45-degree field of view: 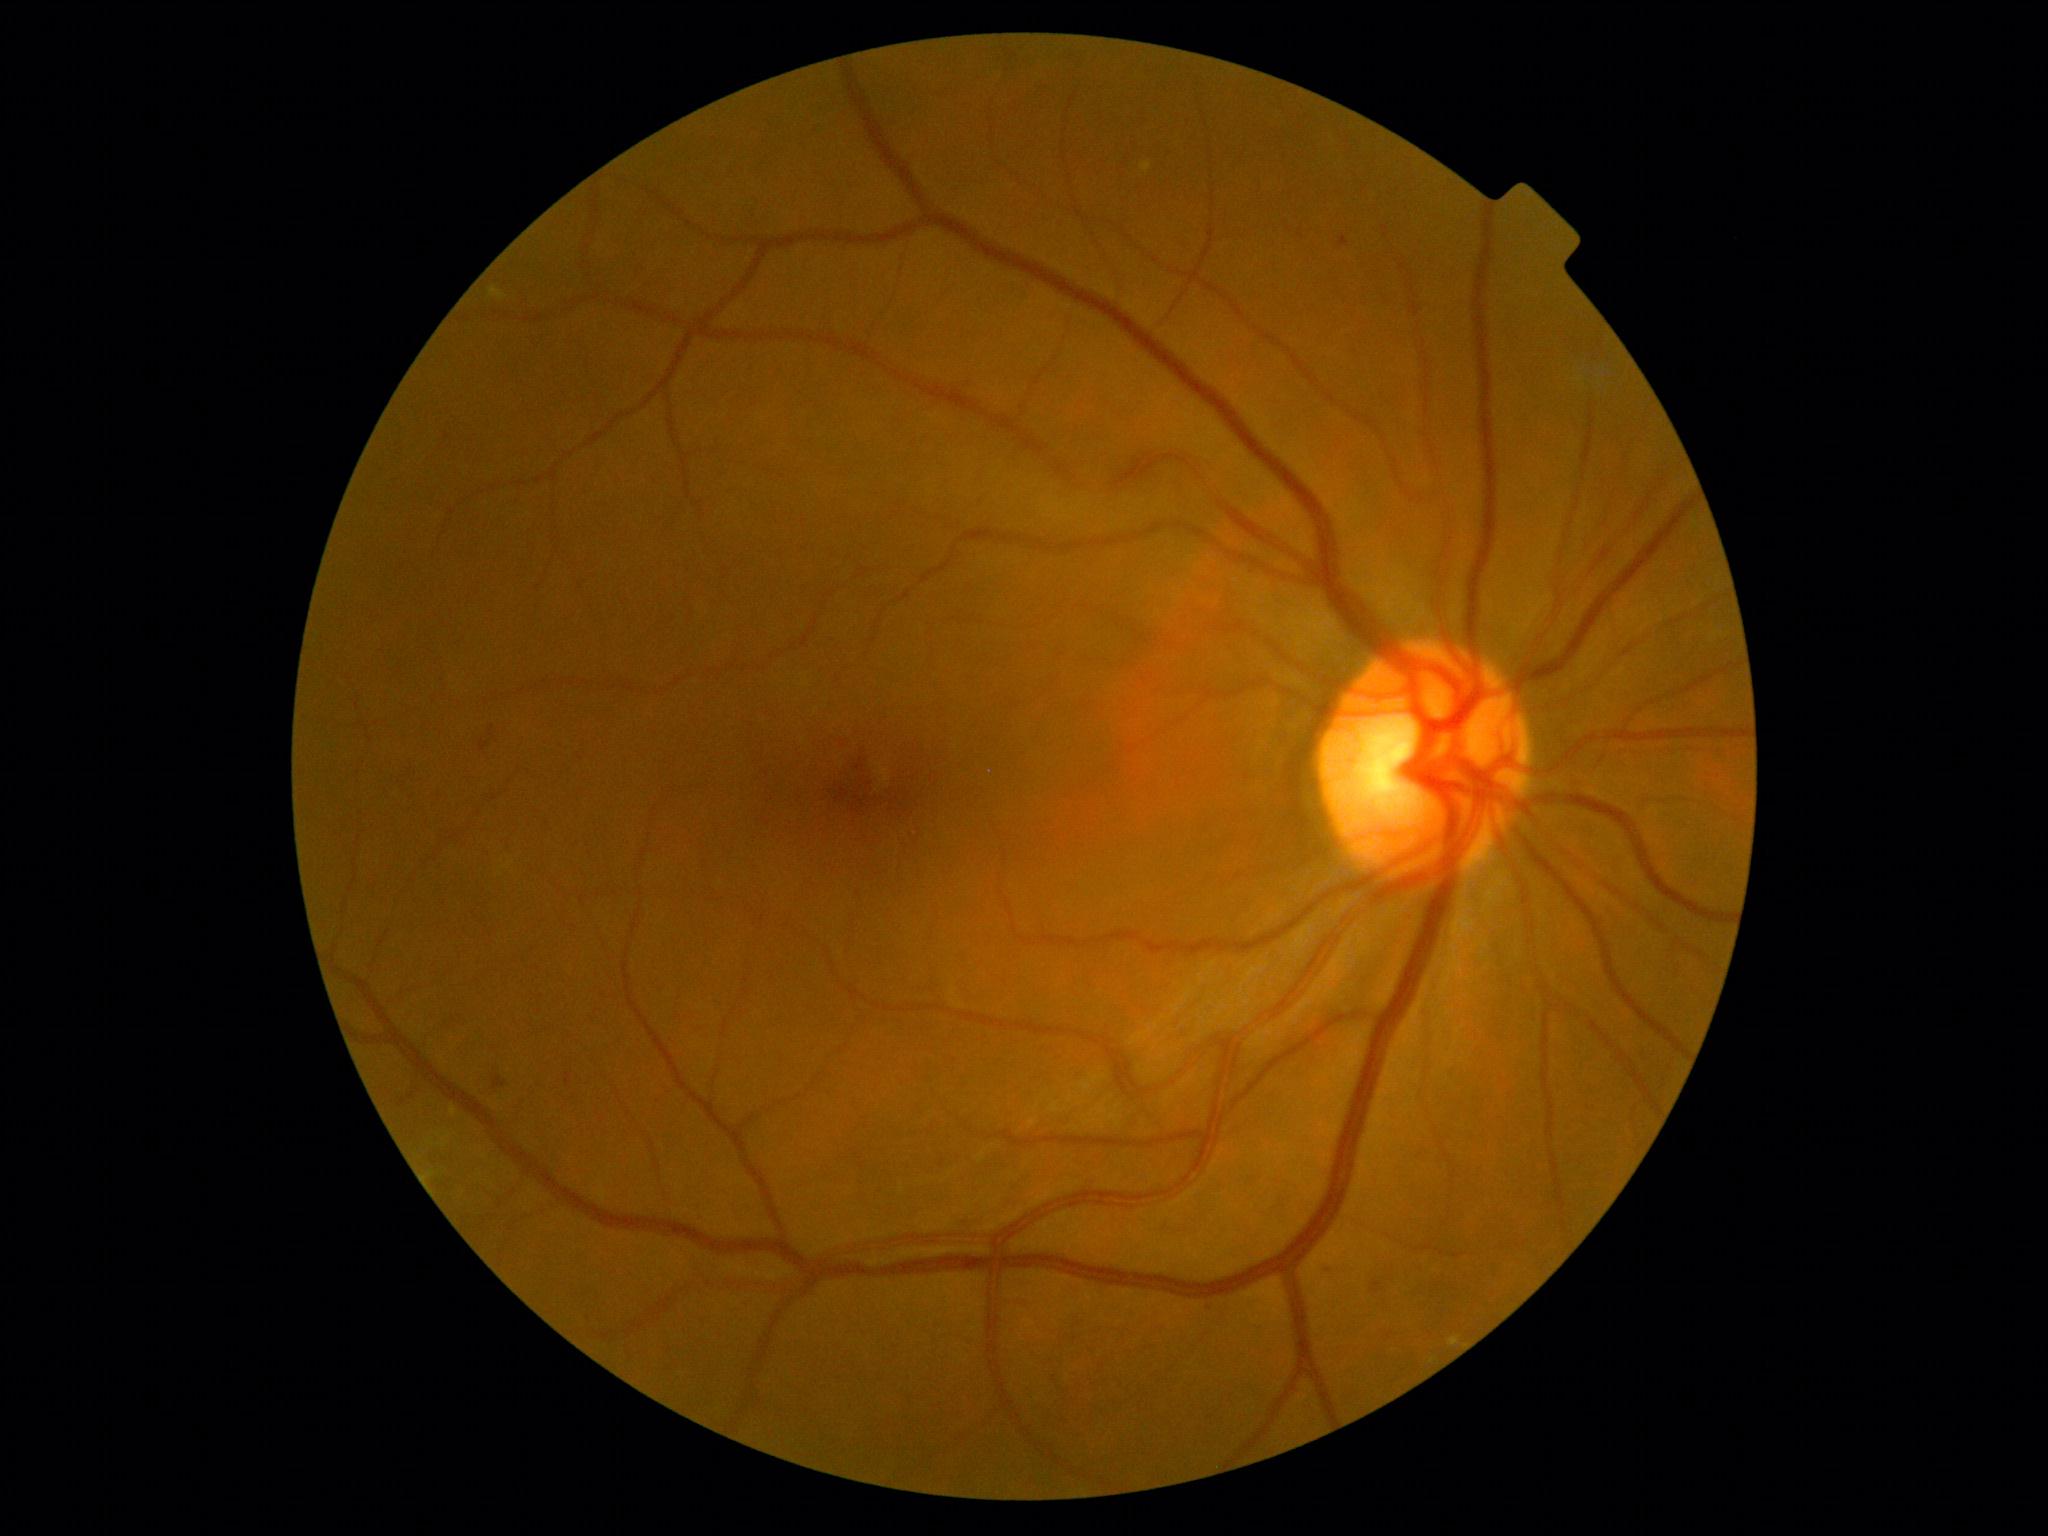 Diabetic retinopathy: 2.